Wide-field fundus photograph from neonatal ROP screening; 100° field of view (Phoenix ICON) — 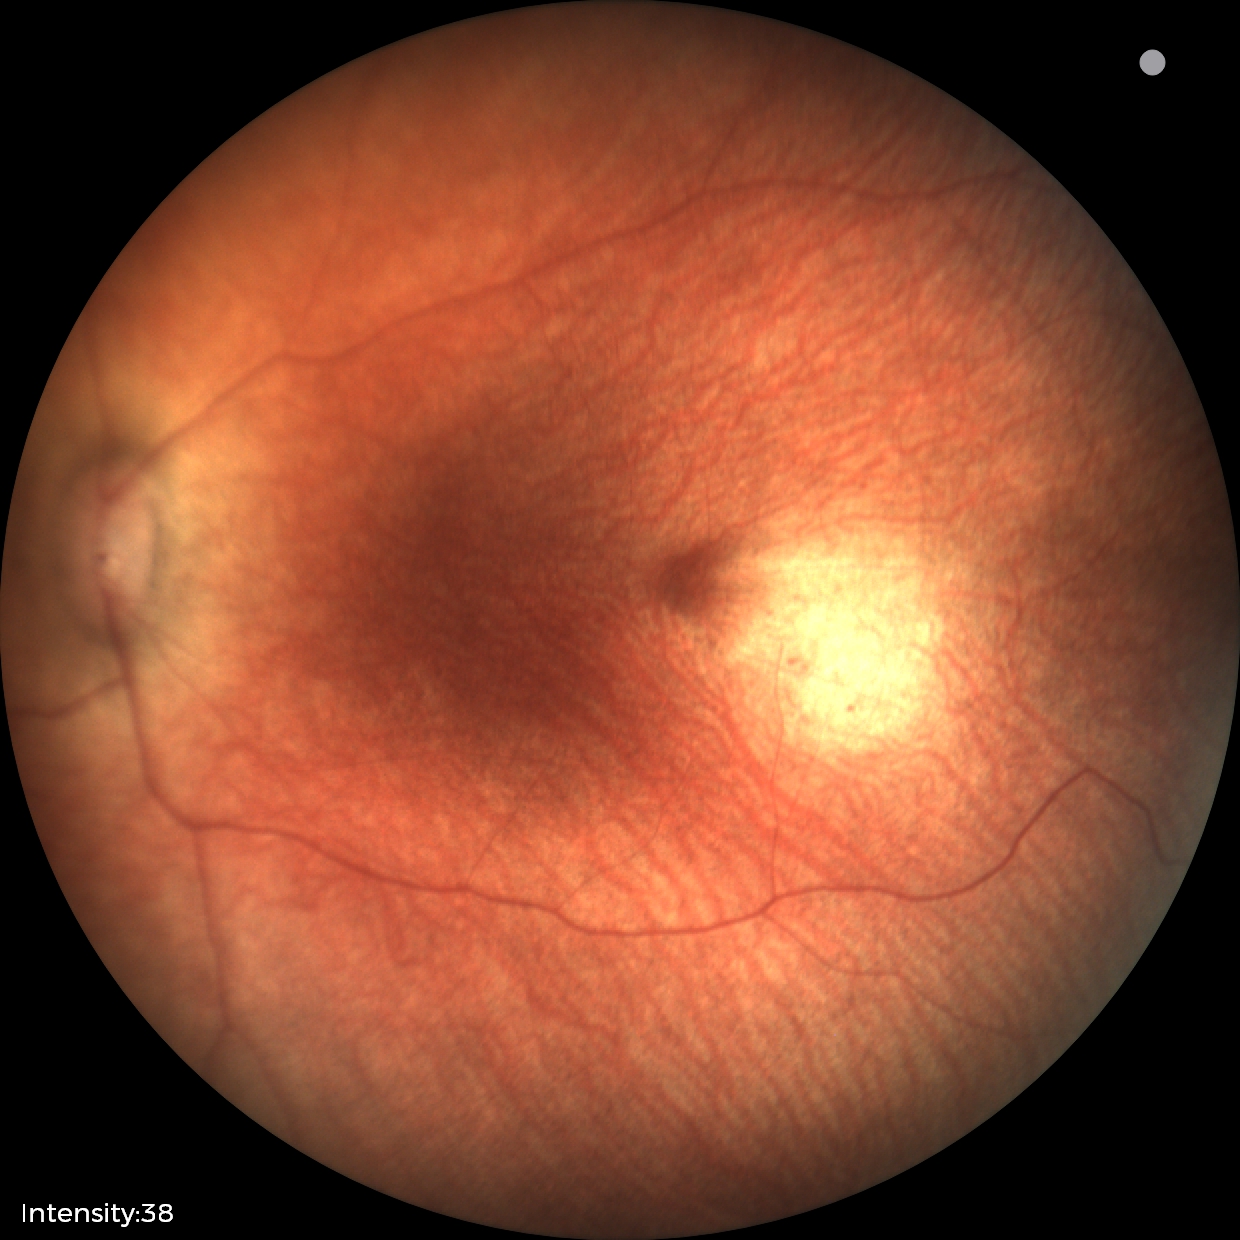 Screening examination diagnosed as physiological.